DR severity per modified Davis staging
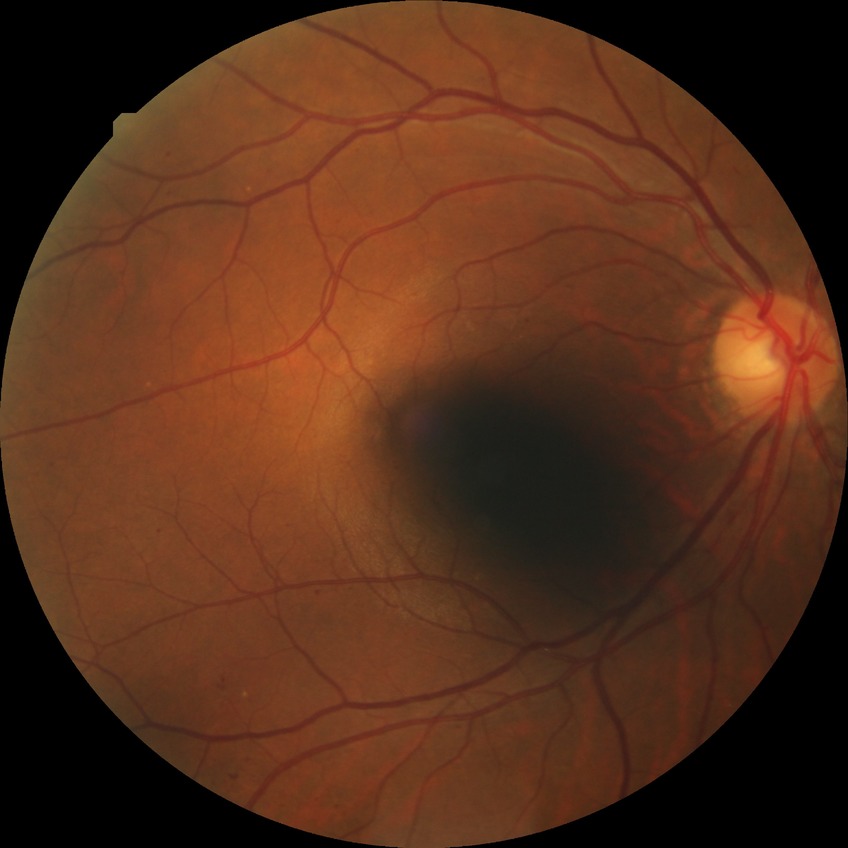 diabetic retinopathy (DR): SDR (simple diabetic retinopathy).